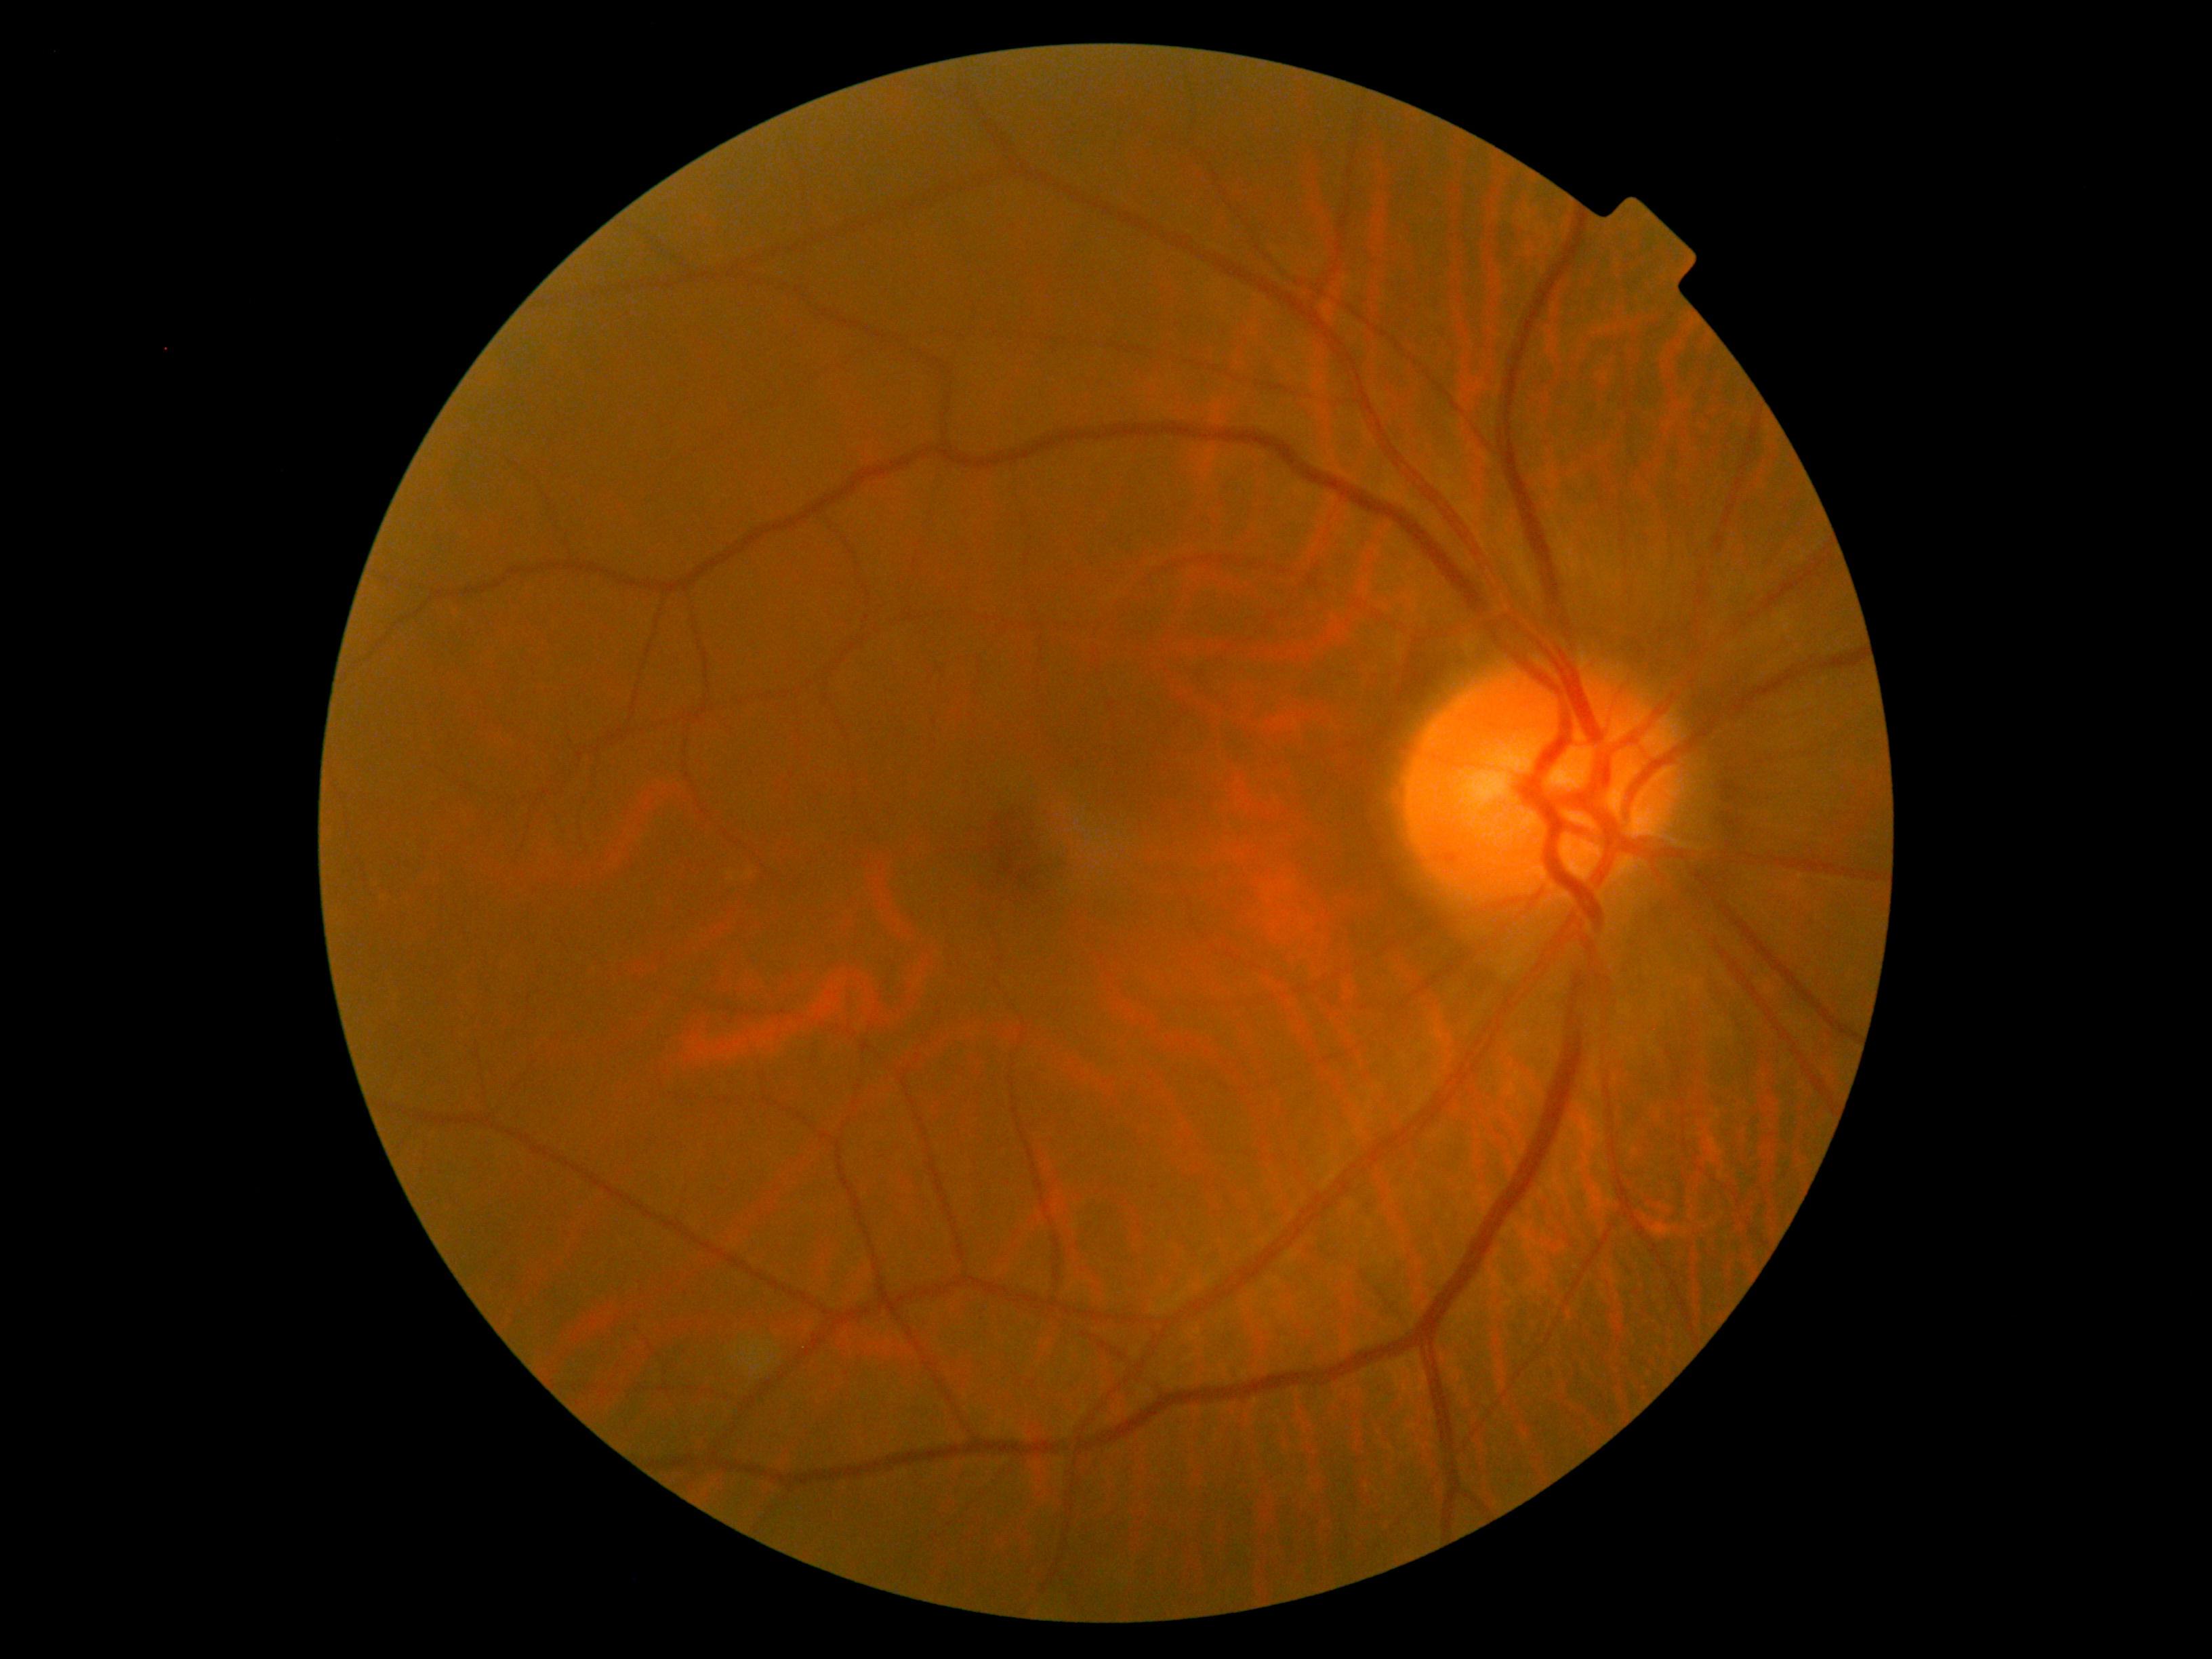
Diabetic retinopathy is no apparent retinopathy (grade 0).
No apparent diabetic retinopathy.